No pharmacologic dilation. Camera: NIDEK AFC-230:
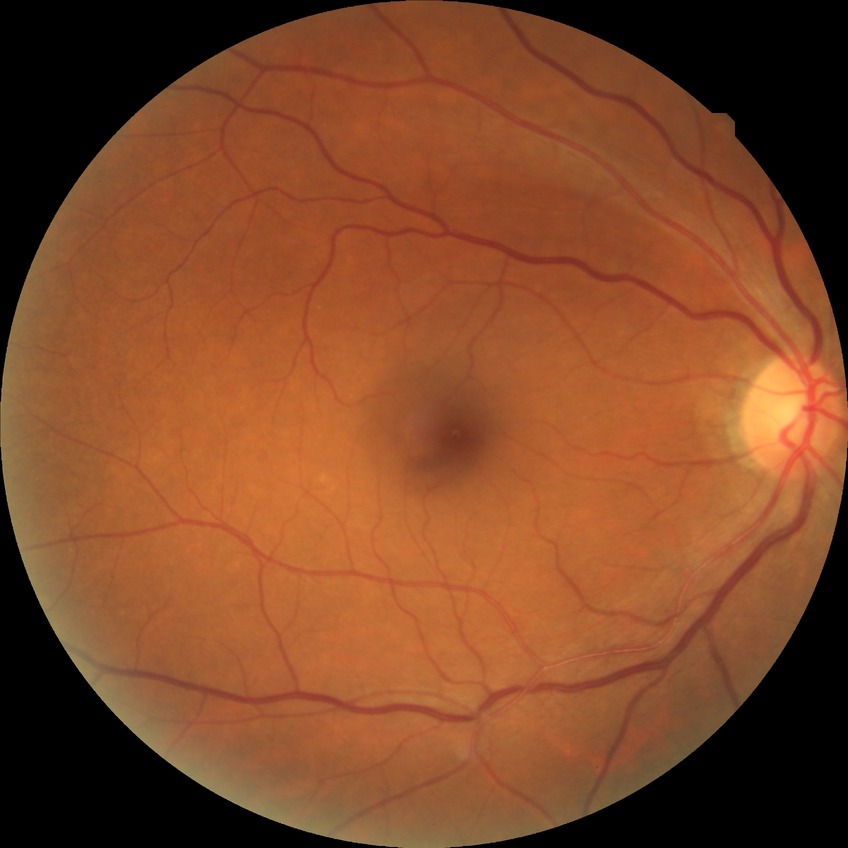
Retinopathy grade: no diabetic retinopathy.